Color fundus image — 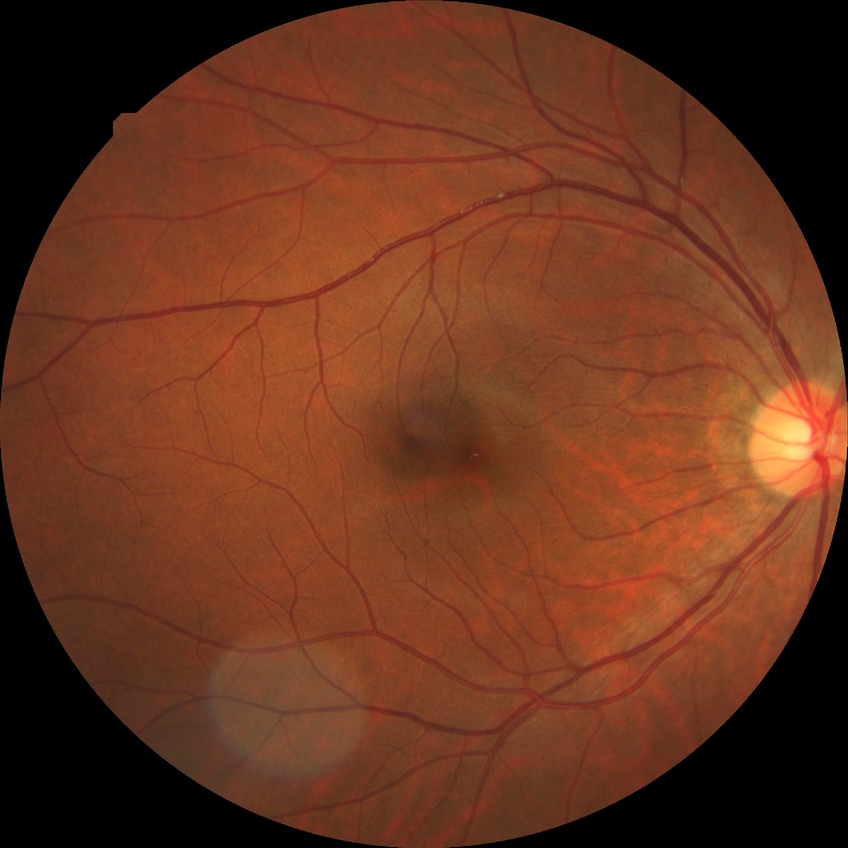 Diabetic retinopathy (DR) is NDR (no diabetic retinopathy).